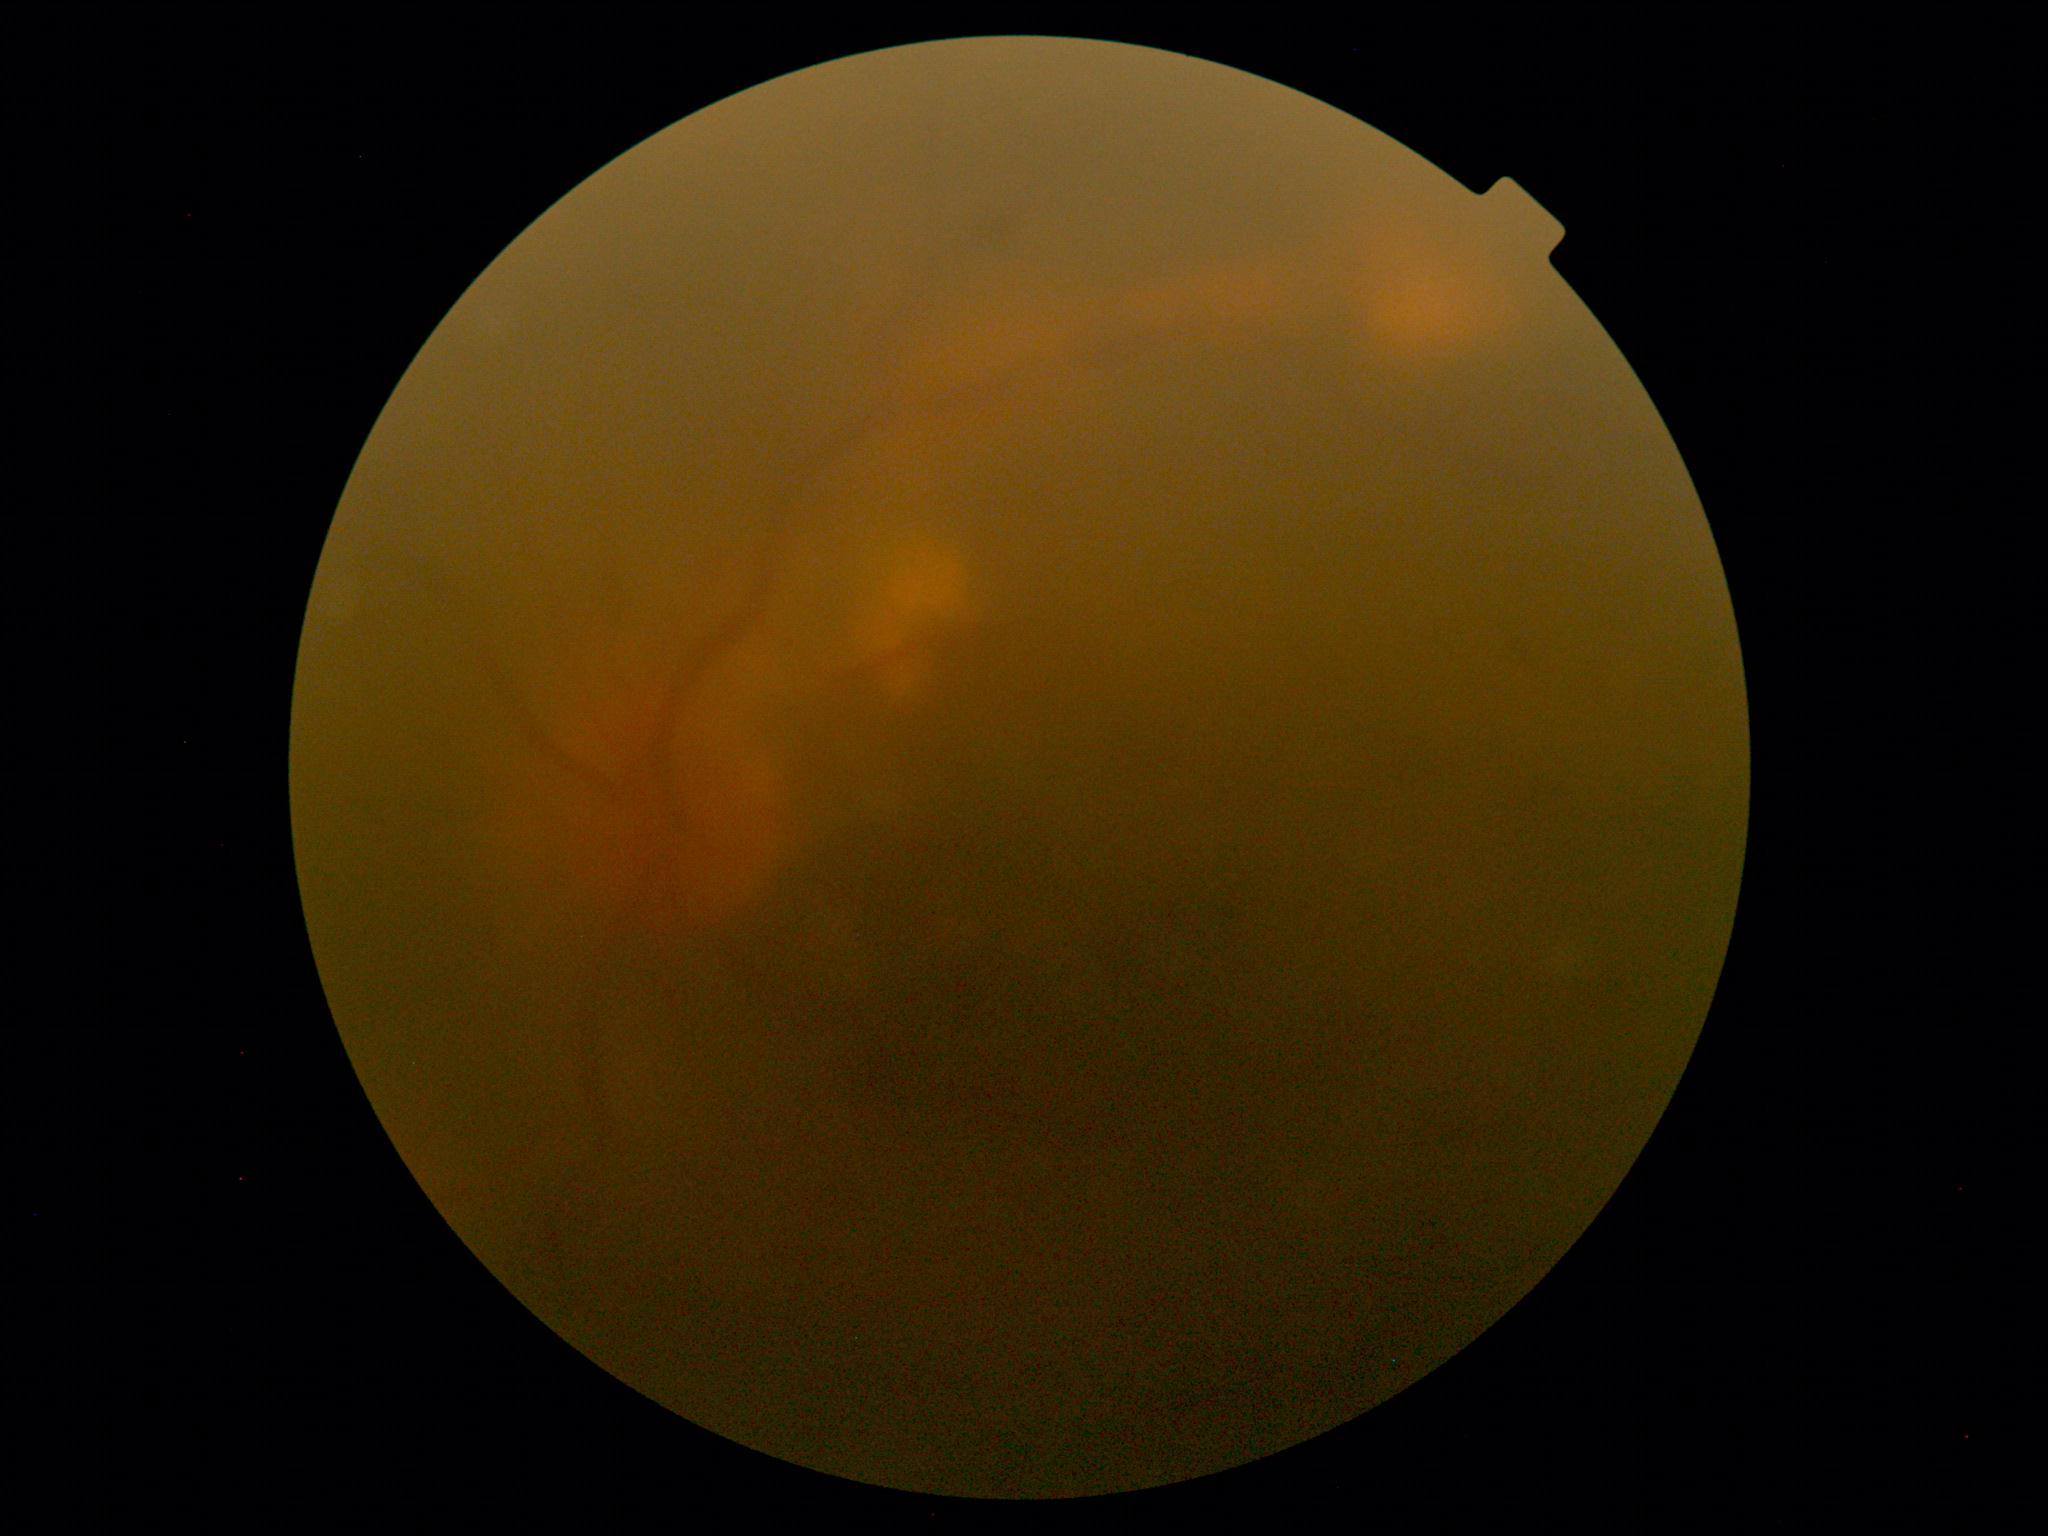

• DR stage: ungradable due to poor image quality
• image quality: too poor for DR grading